Wide-field fundus photograph from neonatal ROP screening
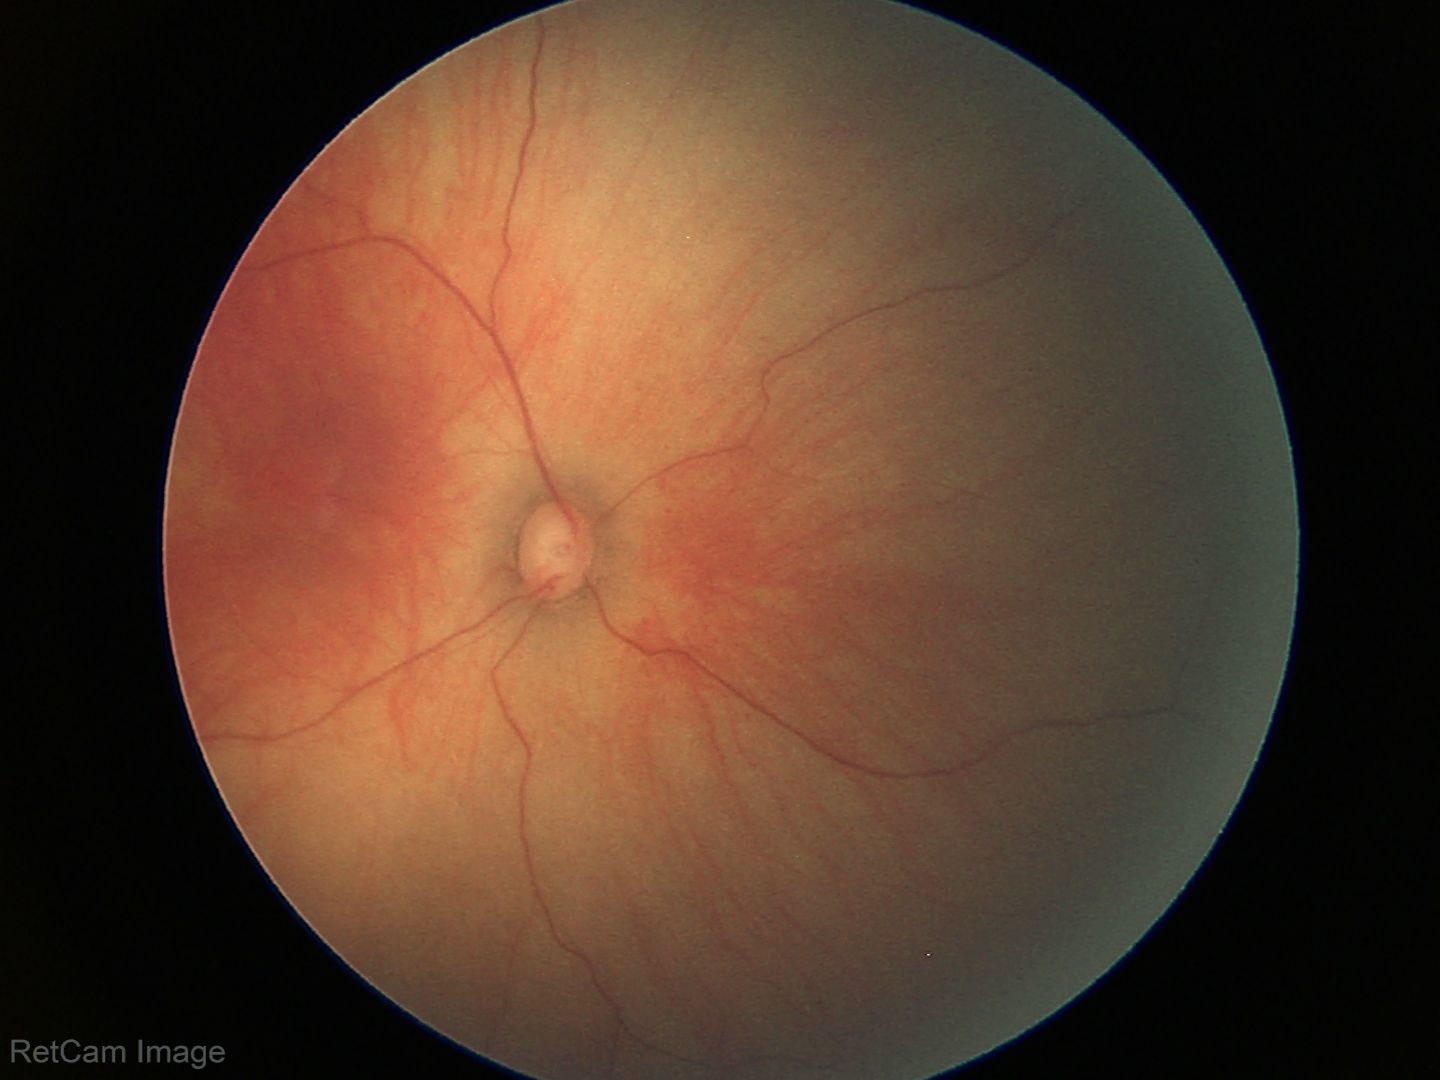
Screening examination with no abnormal retinal findings.